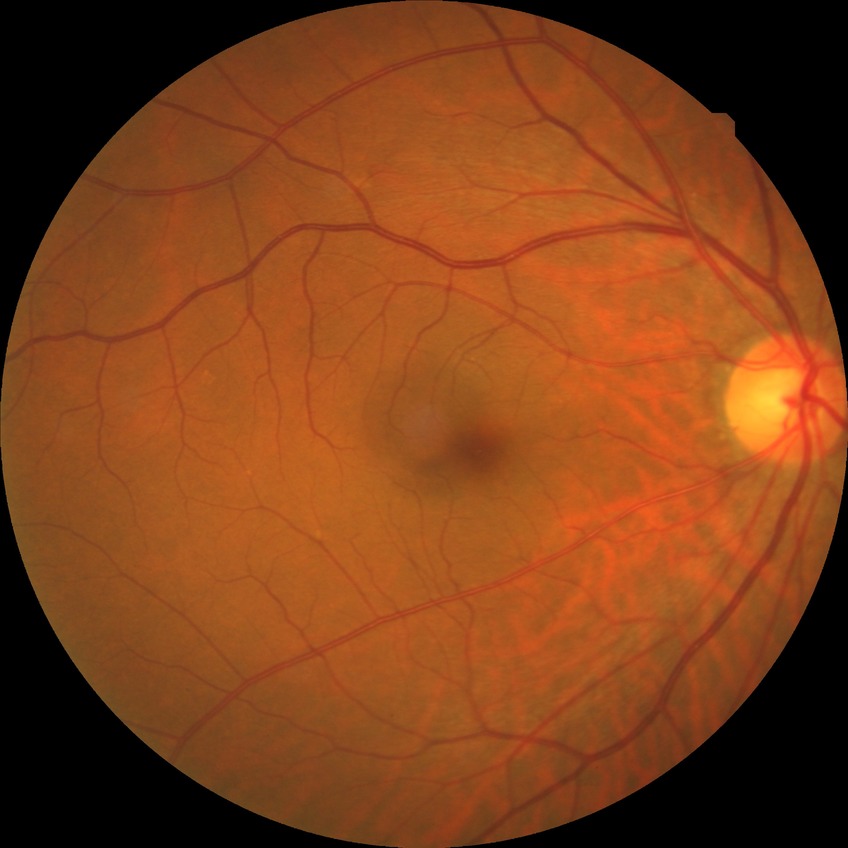
Diabetic retinopathy (DR): NDR (no diabetic retinopathy).